FOV: 45 degrees. Color fundus image:
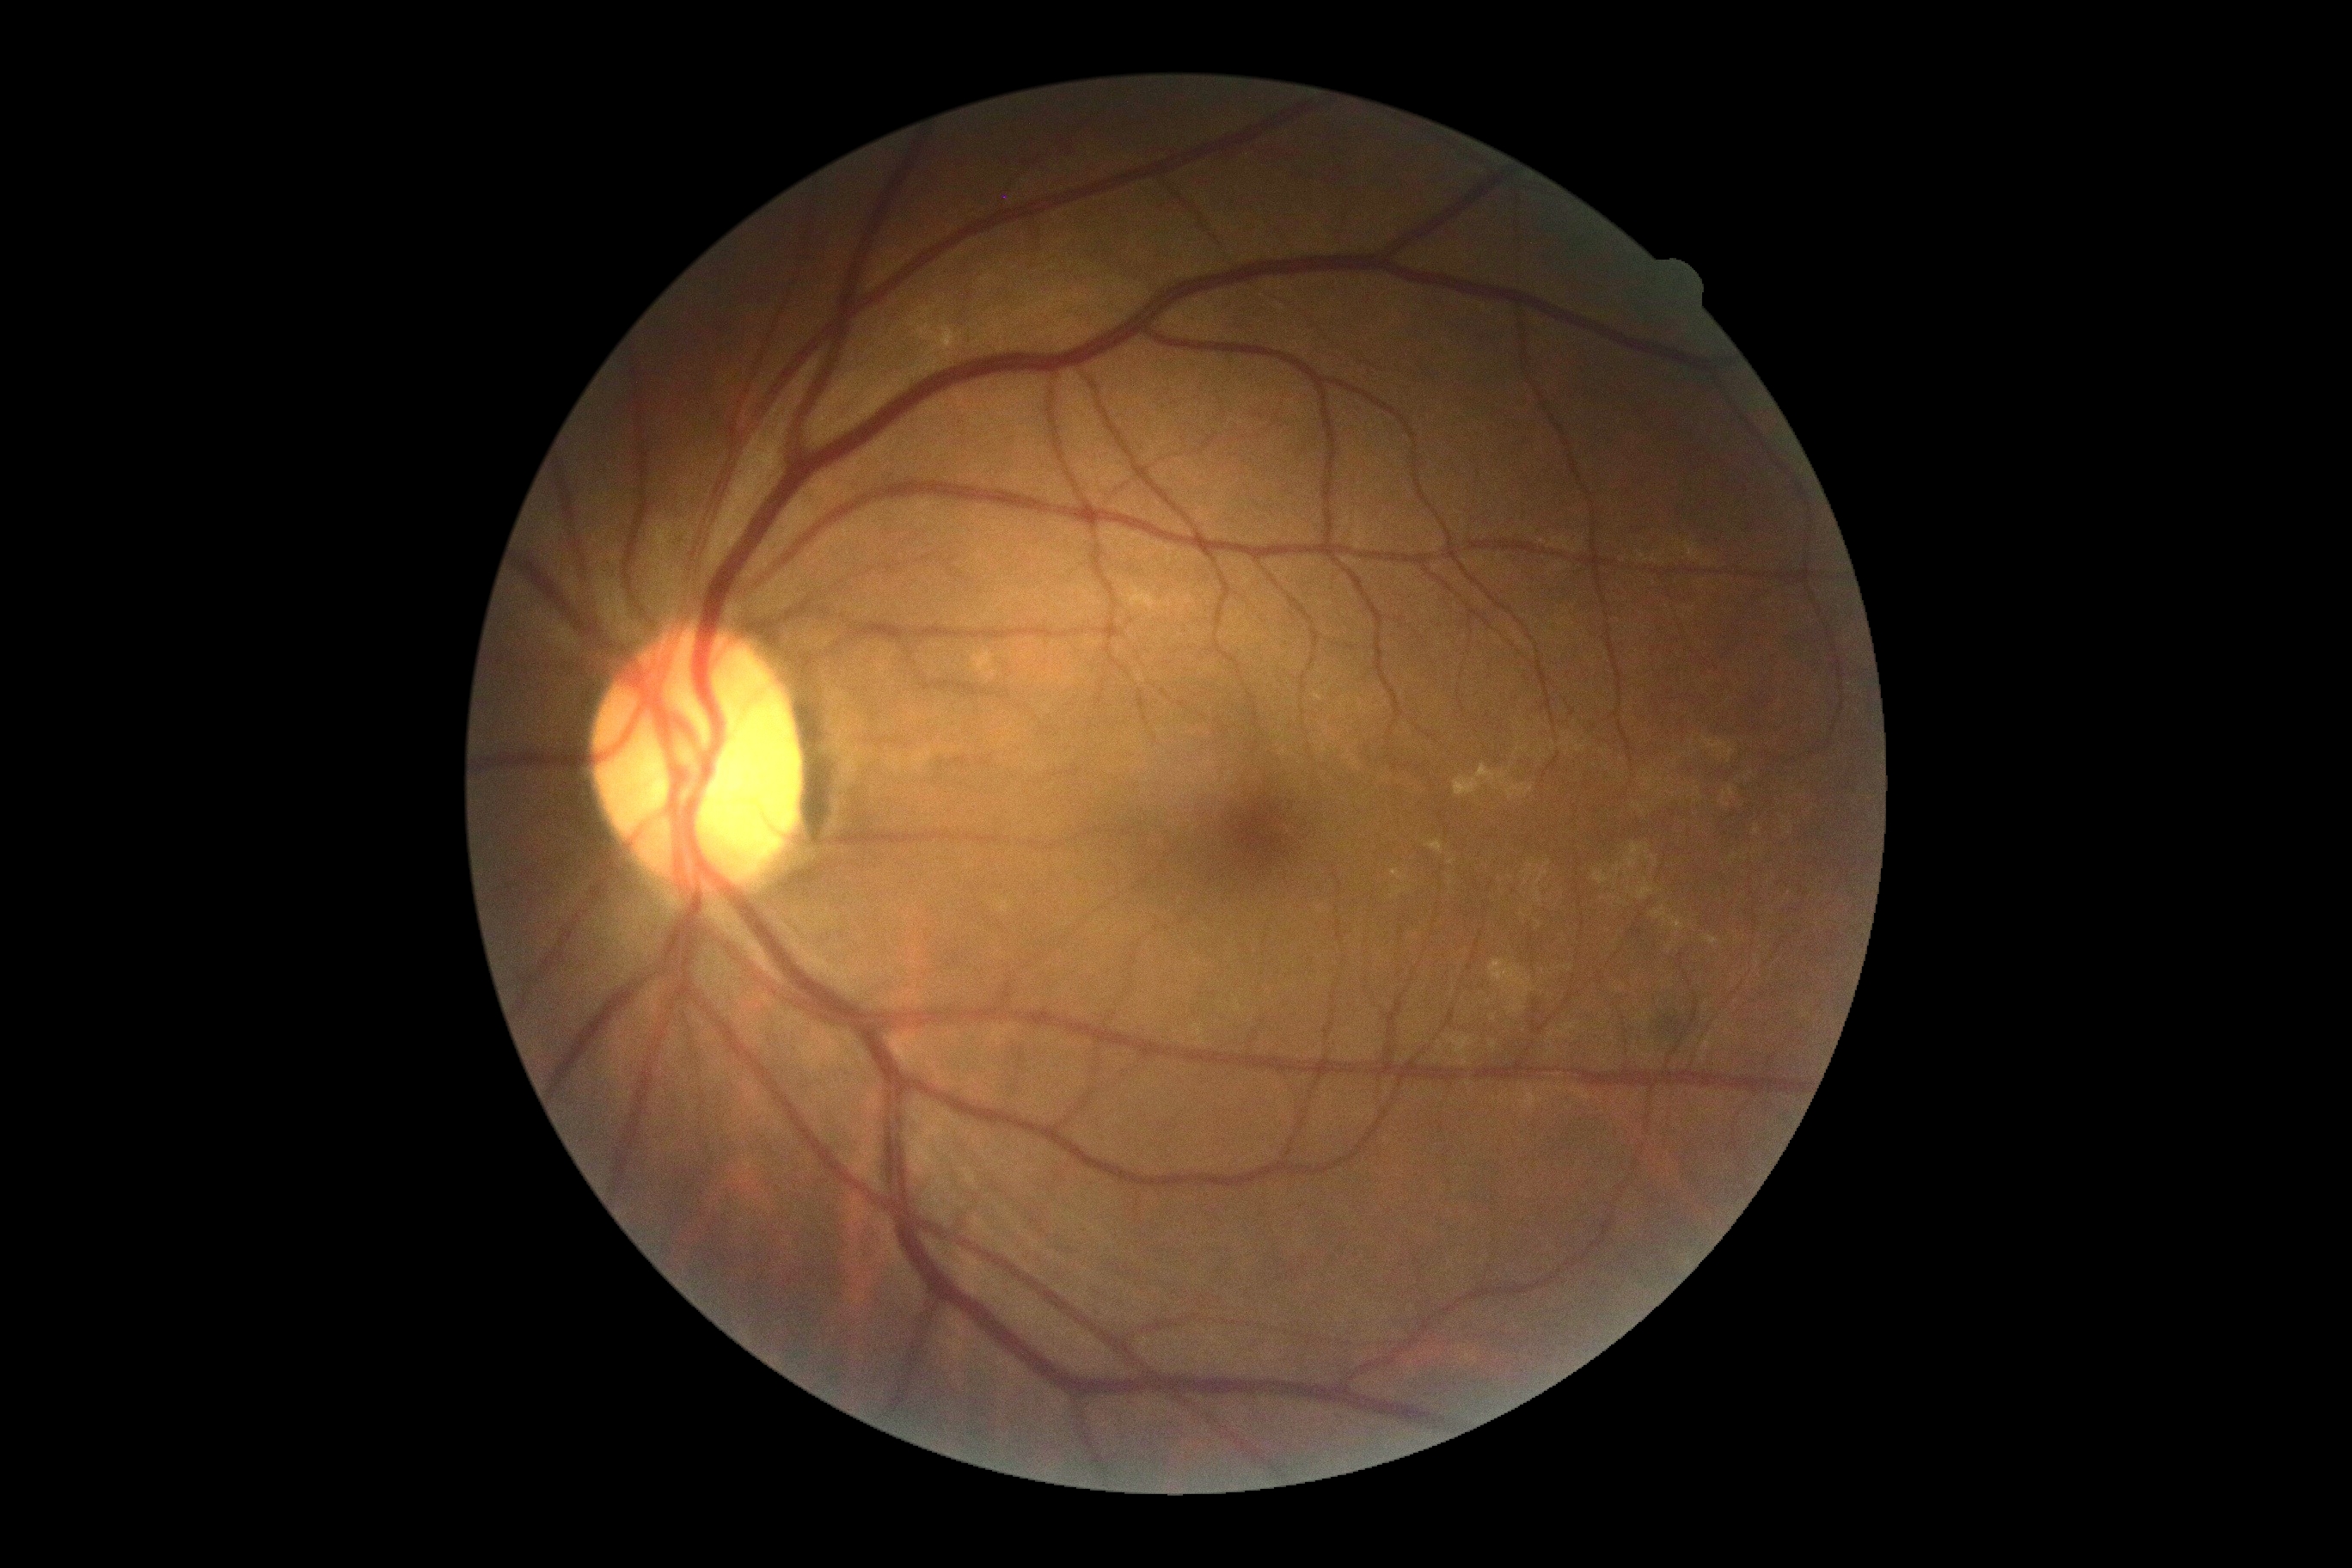 Diabetic retinopathy: grade 0 (no apparent retinopathy).